Retinal fundus photograph.
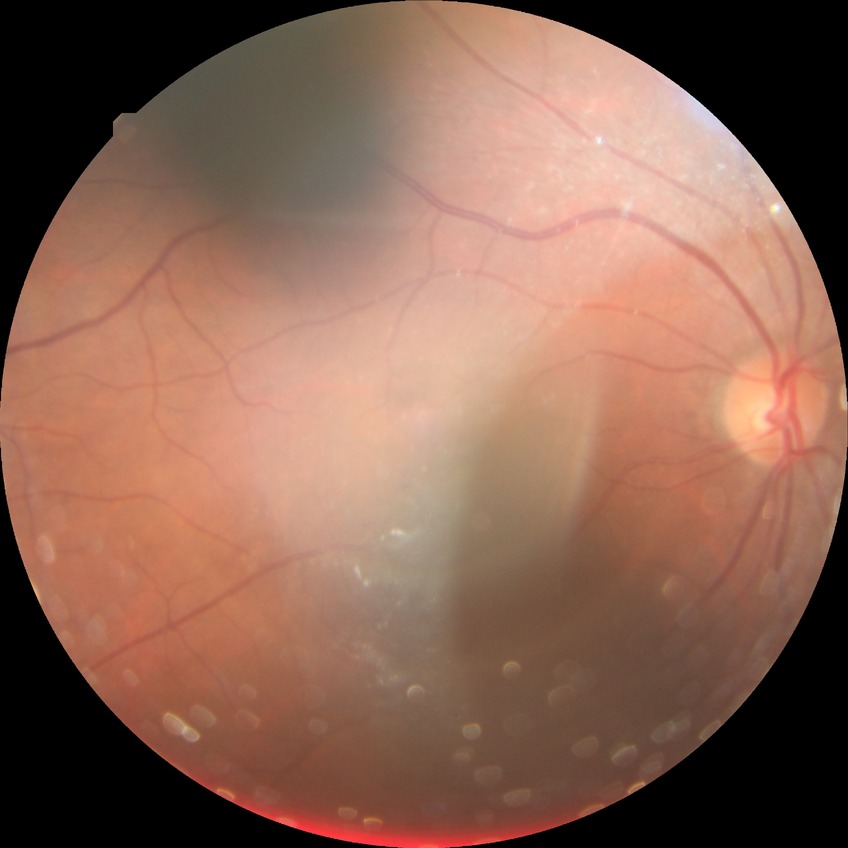
Diabetic retinopathy (DR): simple diabetic retinopathy (SDR).